Davis DR grading, posterior pole color fundus photograph: 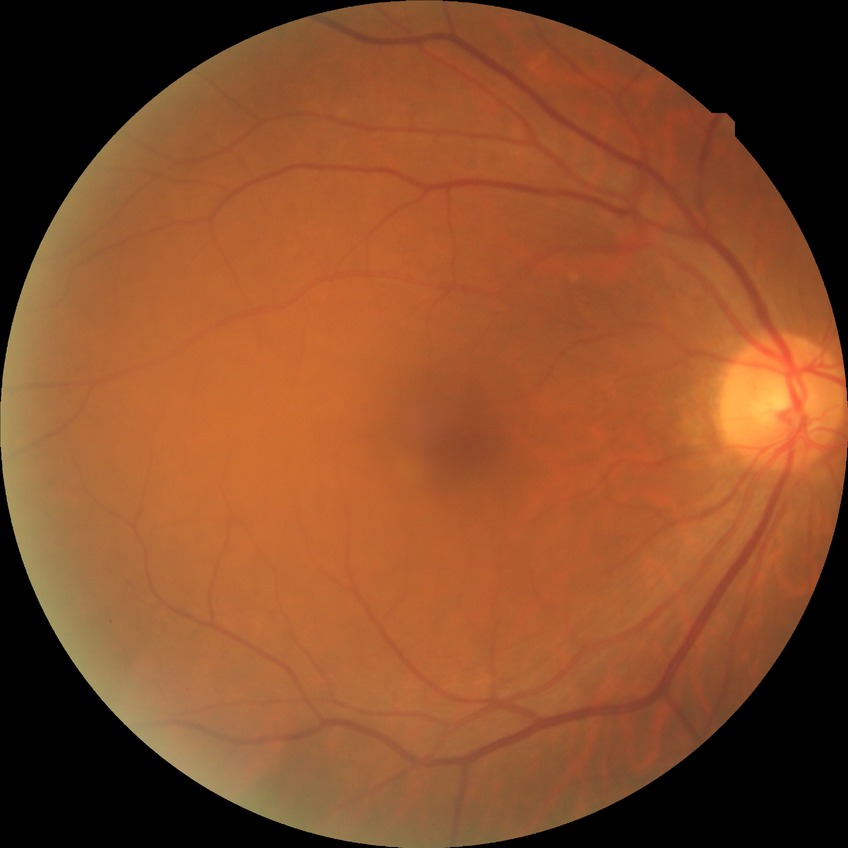
Davis grading is no diabetic retinopathy.